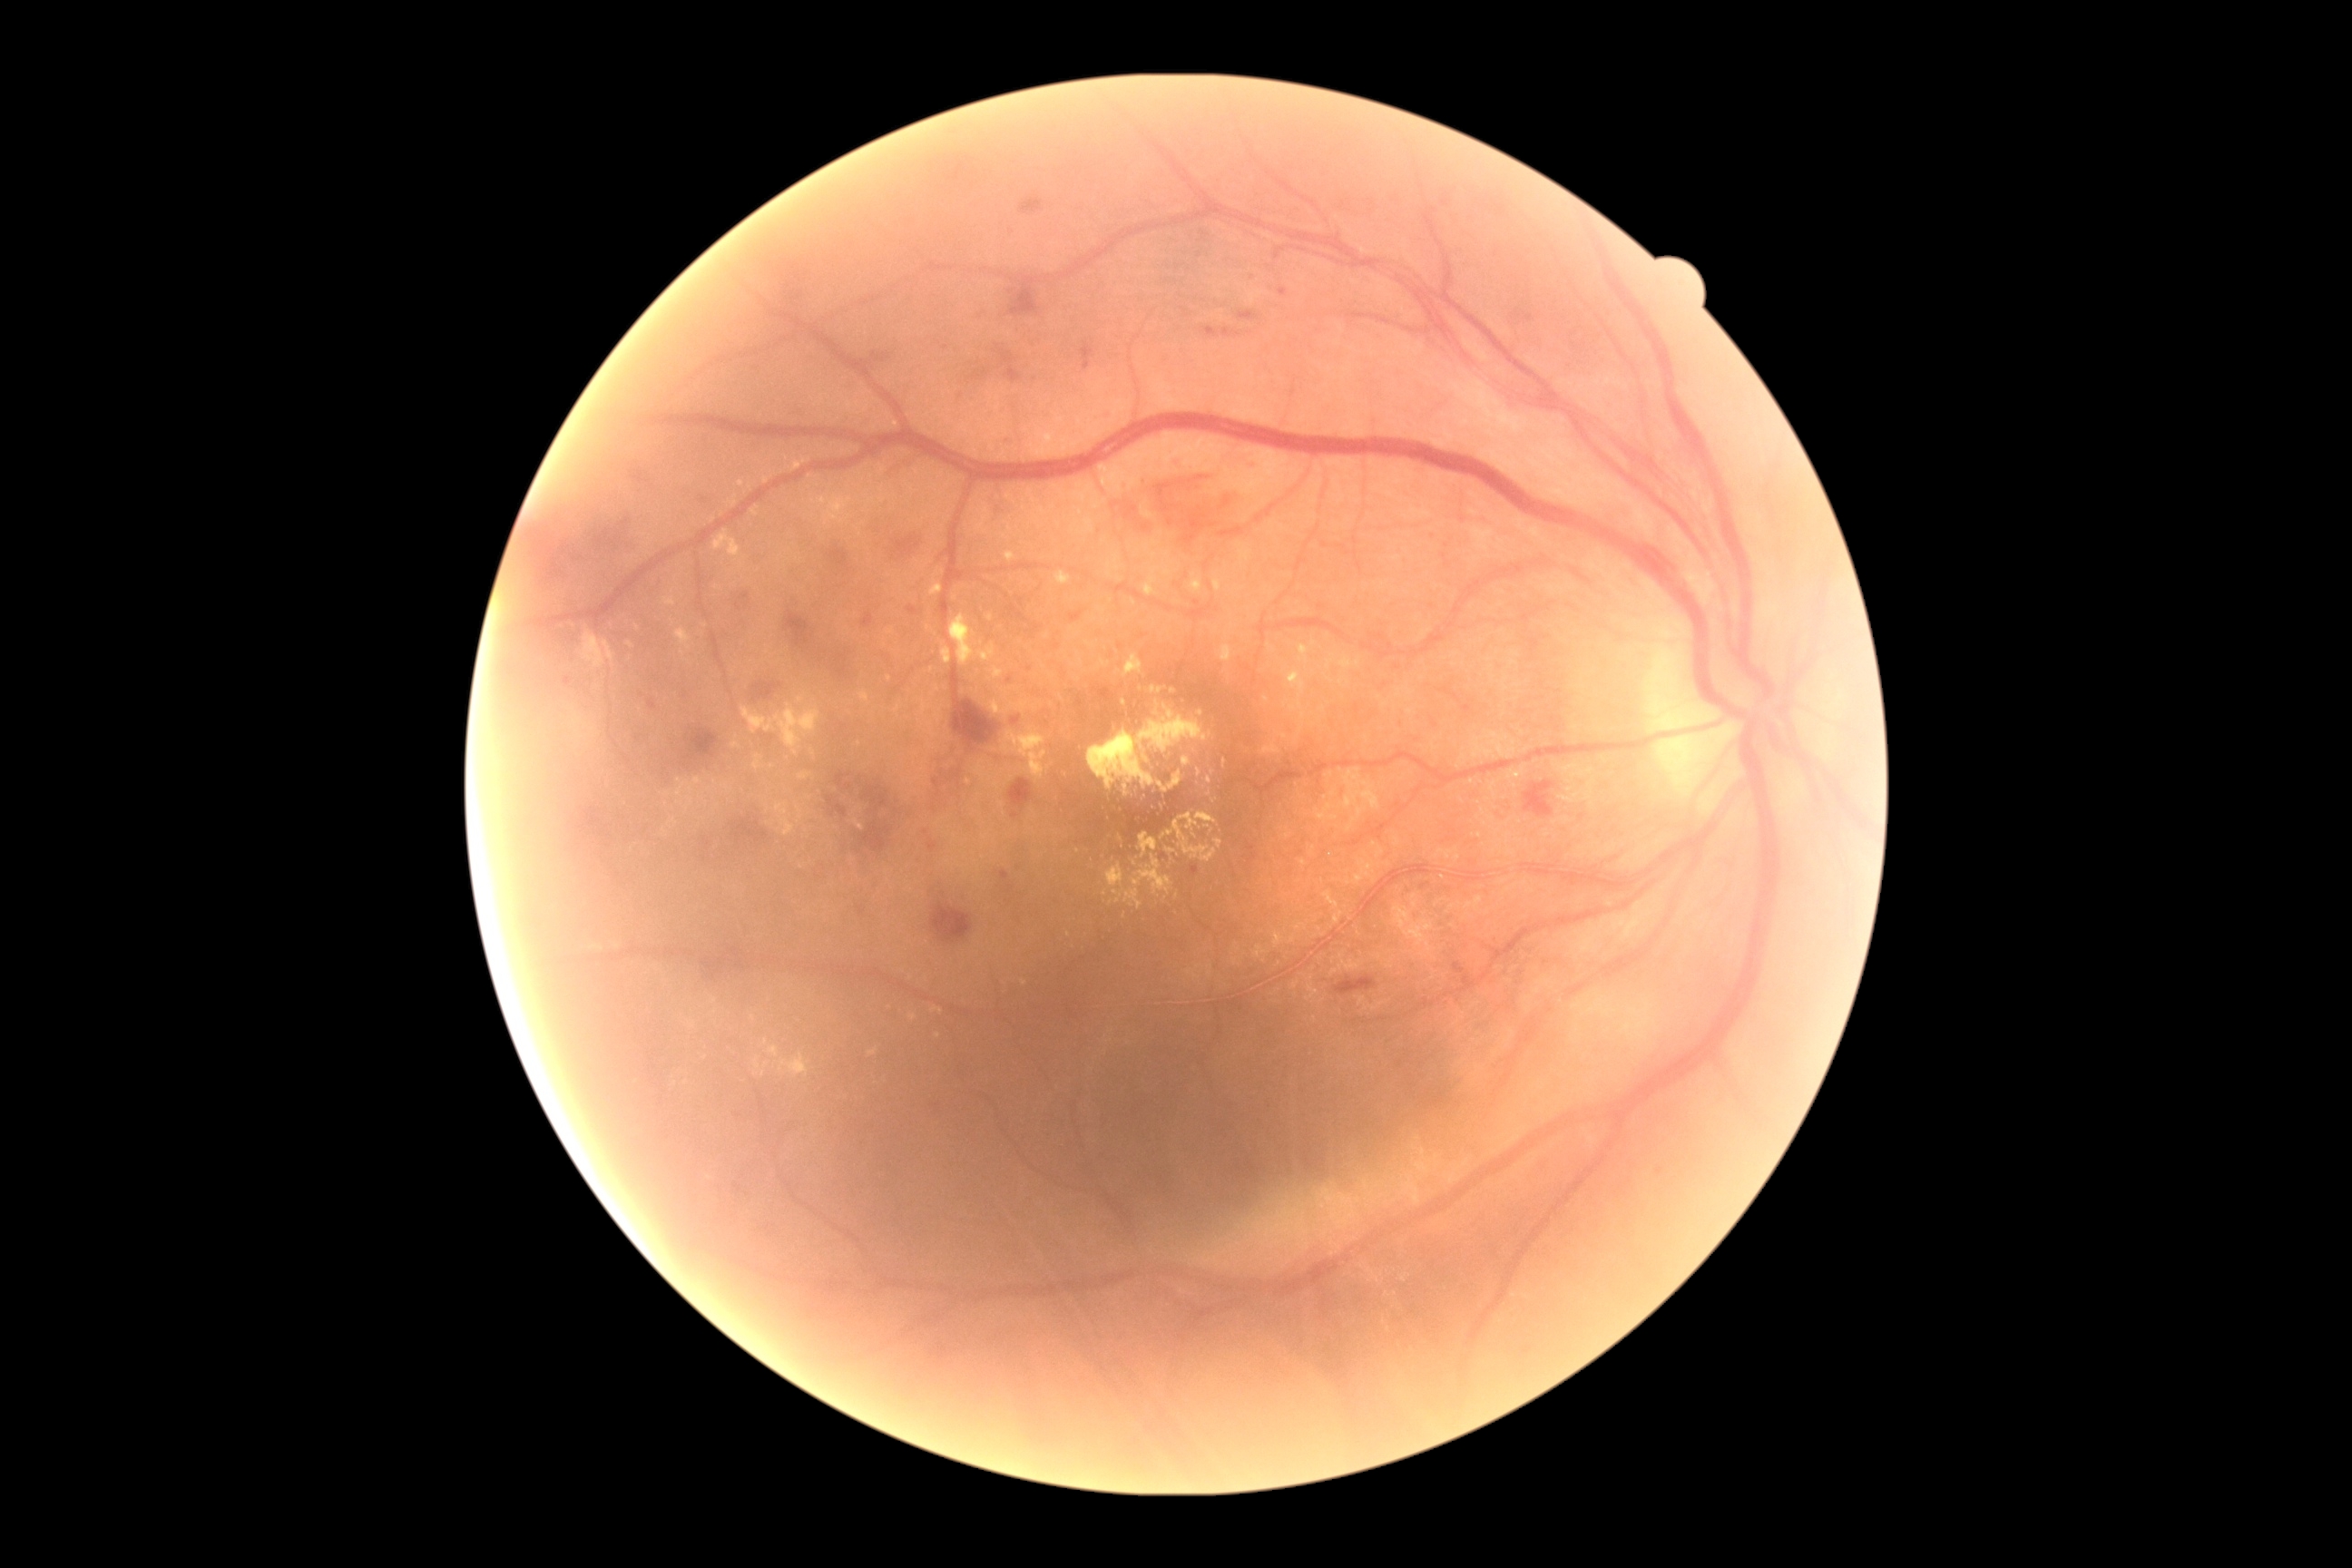
{"partial": true, "dr_grade": 2, "lesions": {"he": [[906, 605, 917, 616], [696, 491, 716, 509], [994, 502, 1014, 531], [819, 776, 917, 865], [970, 369, 990, 382], [1318, 974, 1377, 995], [785, 257, 816, 309], [828, 547, 848, 569], [678, 729, 727, 779], [1008, 779, 1034, 808], [649, 700, 656, 710]], "he_small_approx": [[1015, 815], [628, 760]], "ex": [[1357, 872, 1367, 888], [983, 700, 1004, 714], [794, 458, 810, 471], [752, 507, 760, 516], [923, 700, 945, 723], [1340, 776, 1391, 838], [1224, 760, 1228, 769], [798, 807, 803, 823], [1289, 705, 1297, 712], [580, 631, 607, 671], [769, 1046, 779, 1057]], "ex_small_approx": [[910, 488], [741, 484], [767, 1066], [672, 622], [938, 689], [1124, 917], [1313, 644]]}}